FOV: 45 degrees: 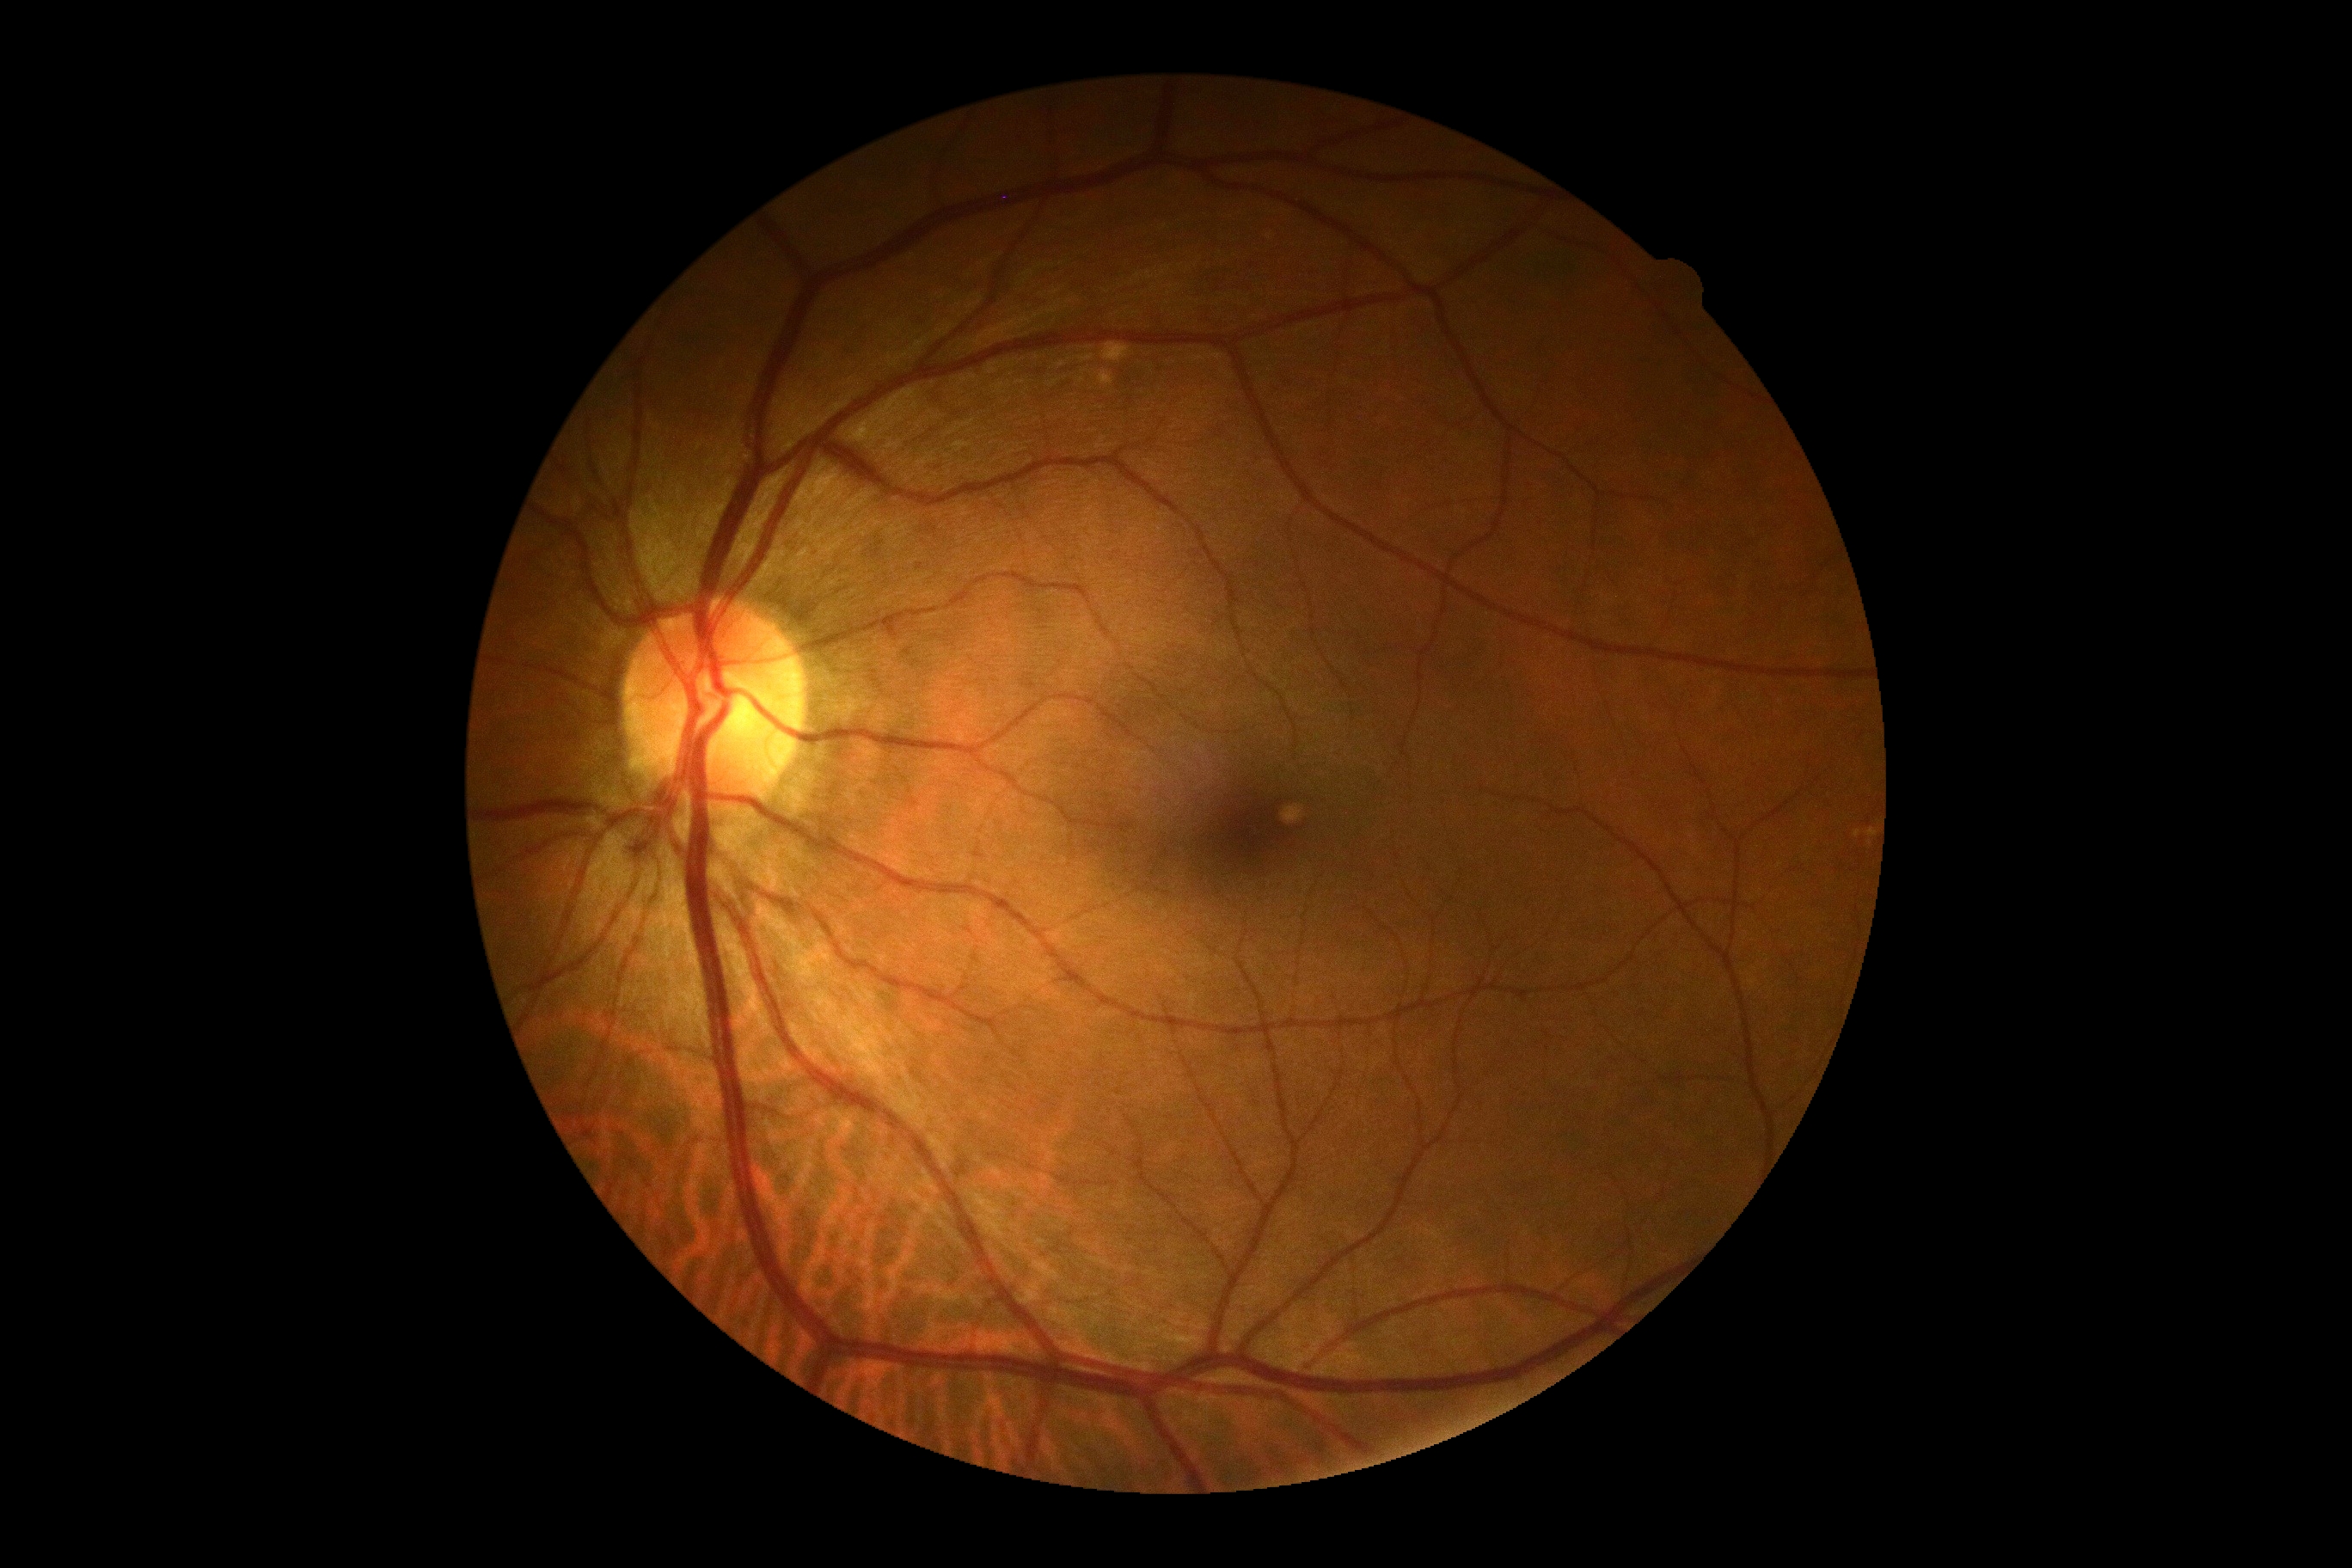
diabetic retinopathy (DR)@grade 0 (no apparent retinopathy).